848x848 · without pupil dilation · fundus photo · NIDEK AFC-230
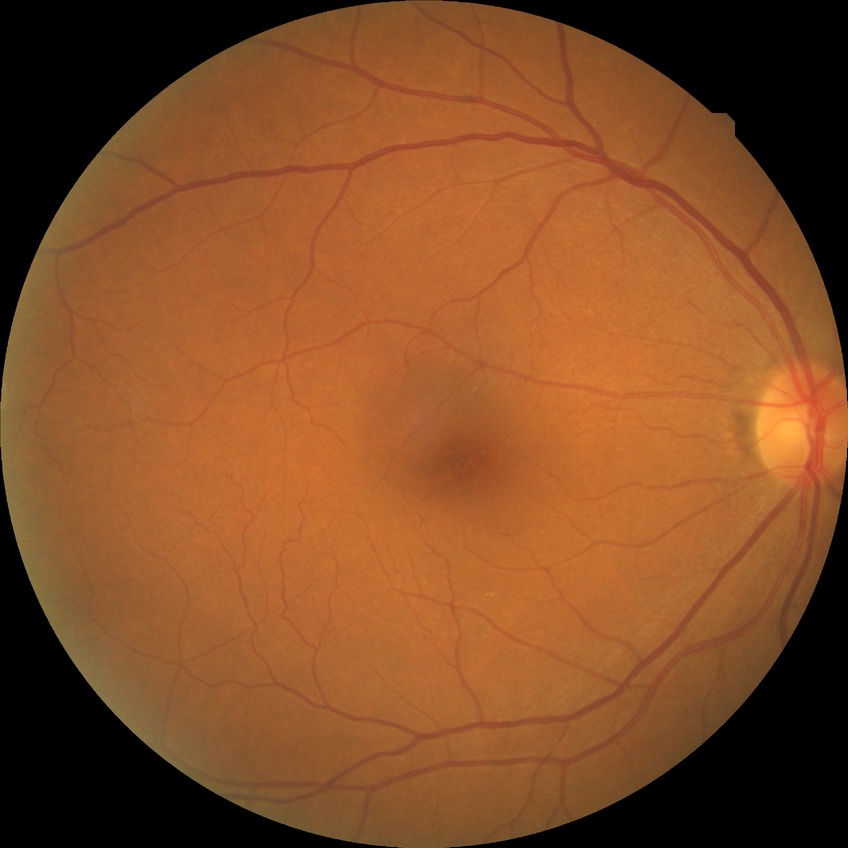
Assessment:
– diabetic retinopathy (DR): no diabetic retinopathy (NDR)